No pharmacologic dilation
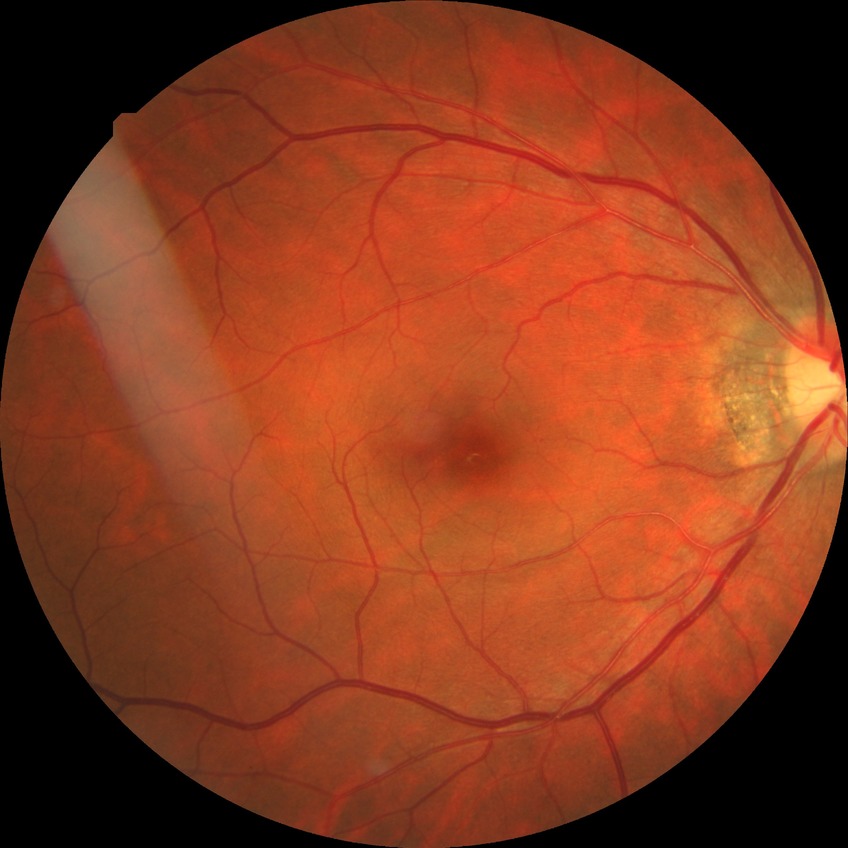

diabetic retinopathy stage = no diabetic retinopathy.